CFP; 30° field of view; disc-centered field; 2212x1661; captured on a Topcon TRC-NW400 fundus camera; captured without pupil dilation.
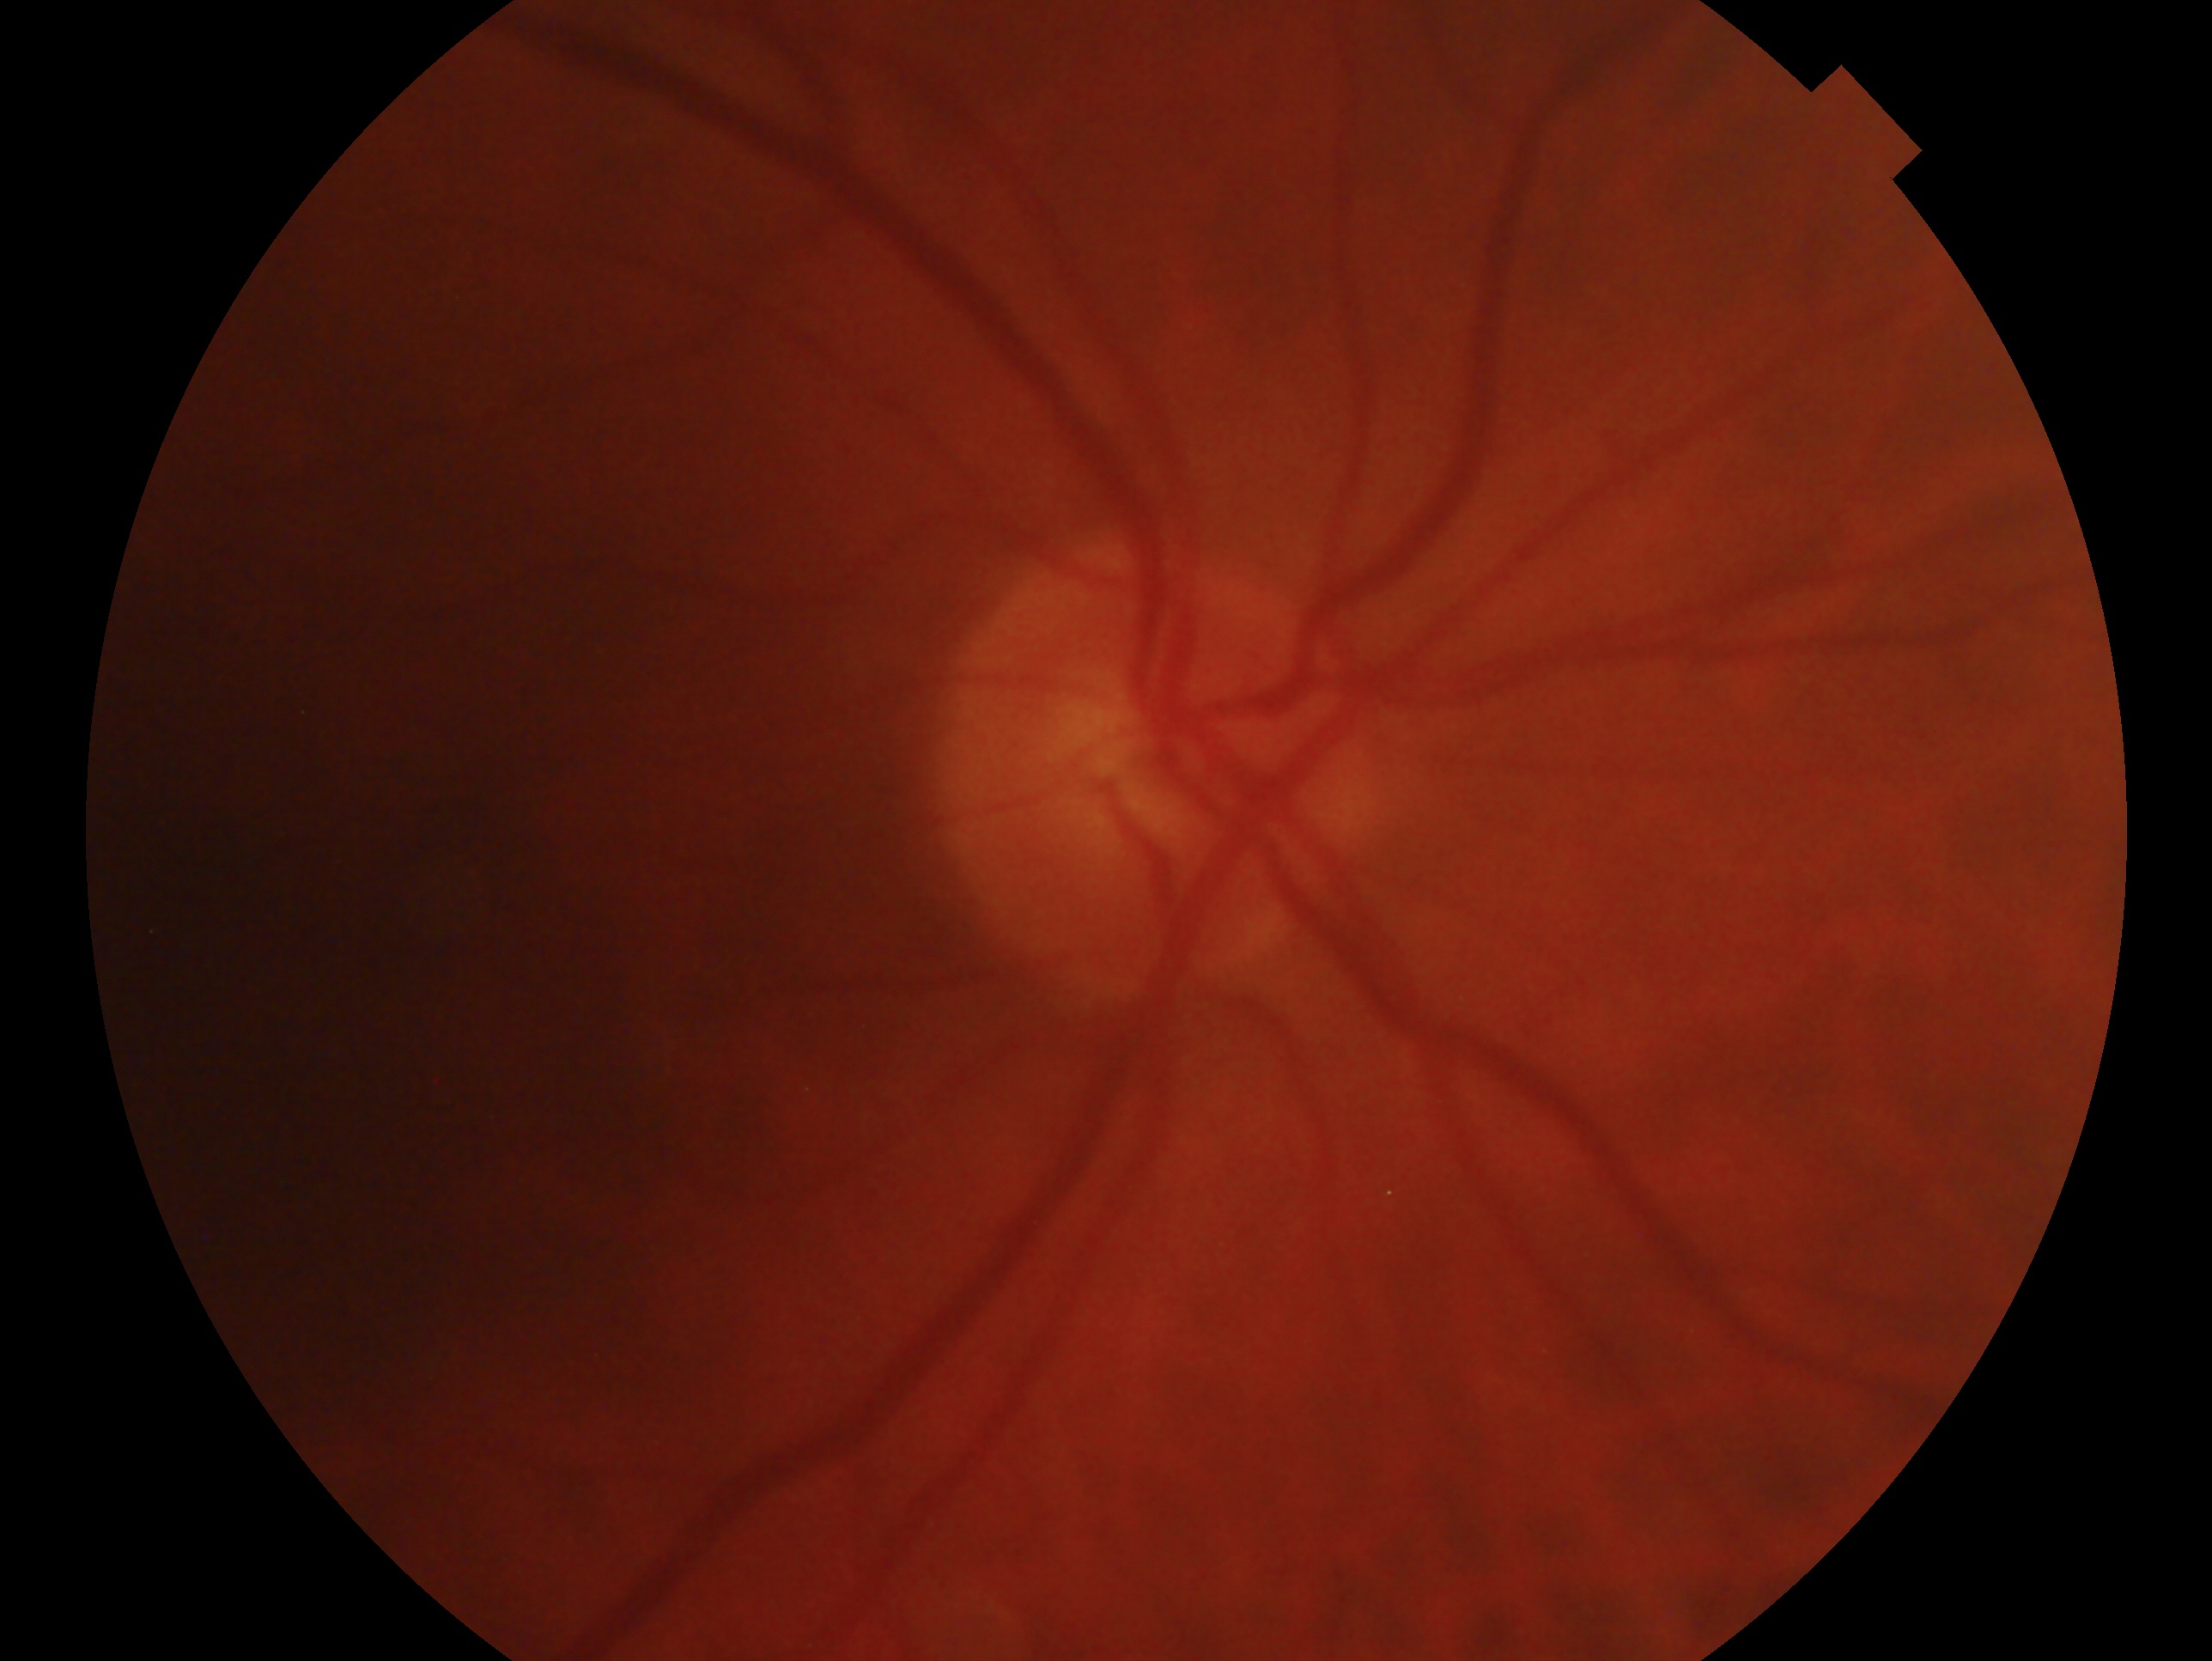

{
  "eye": "oculus dexter",
  "glaucoma_dx": "negative for glaucoma"
}